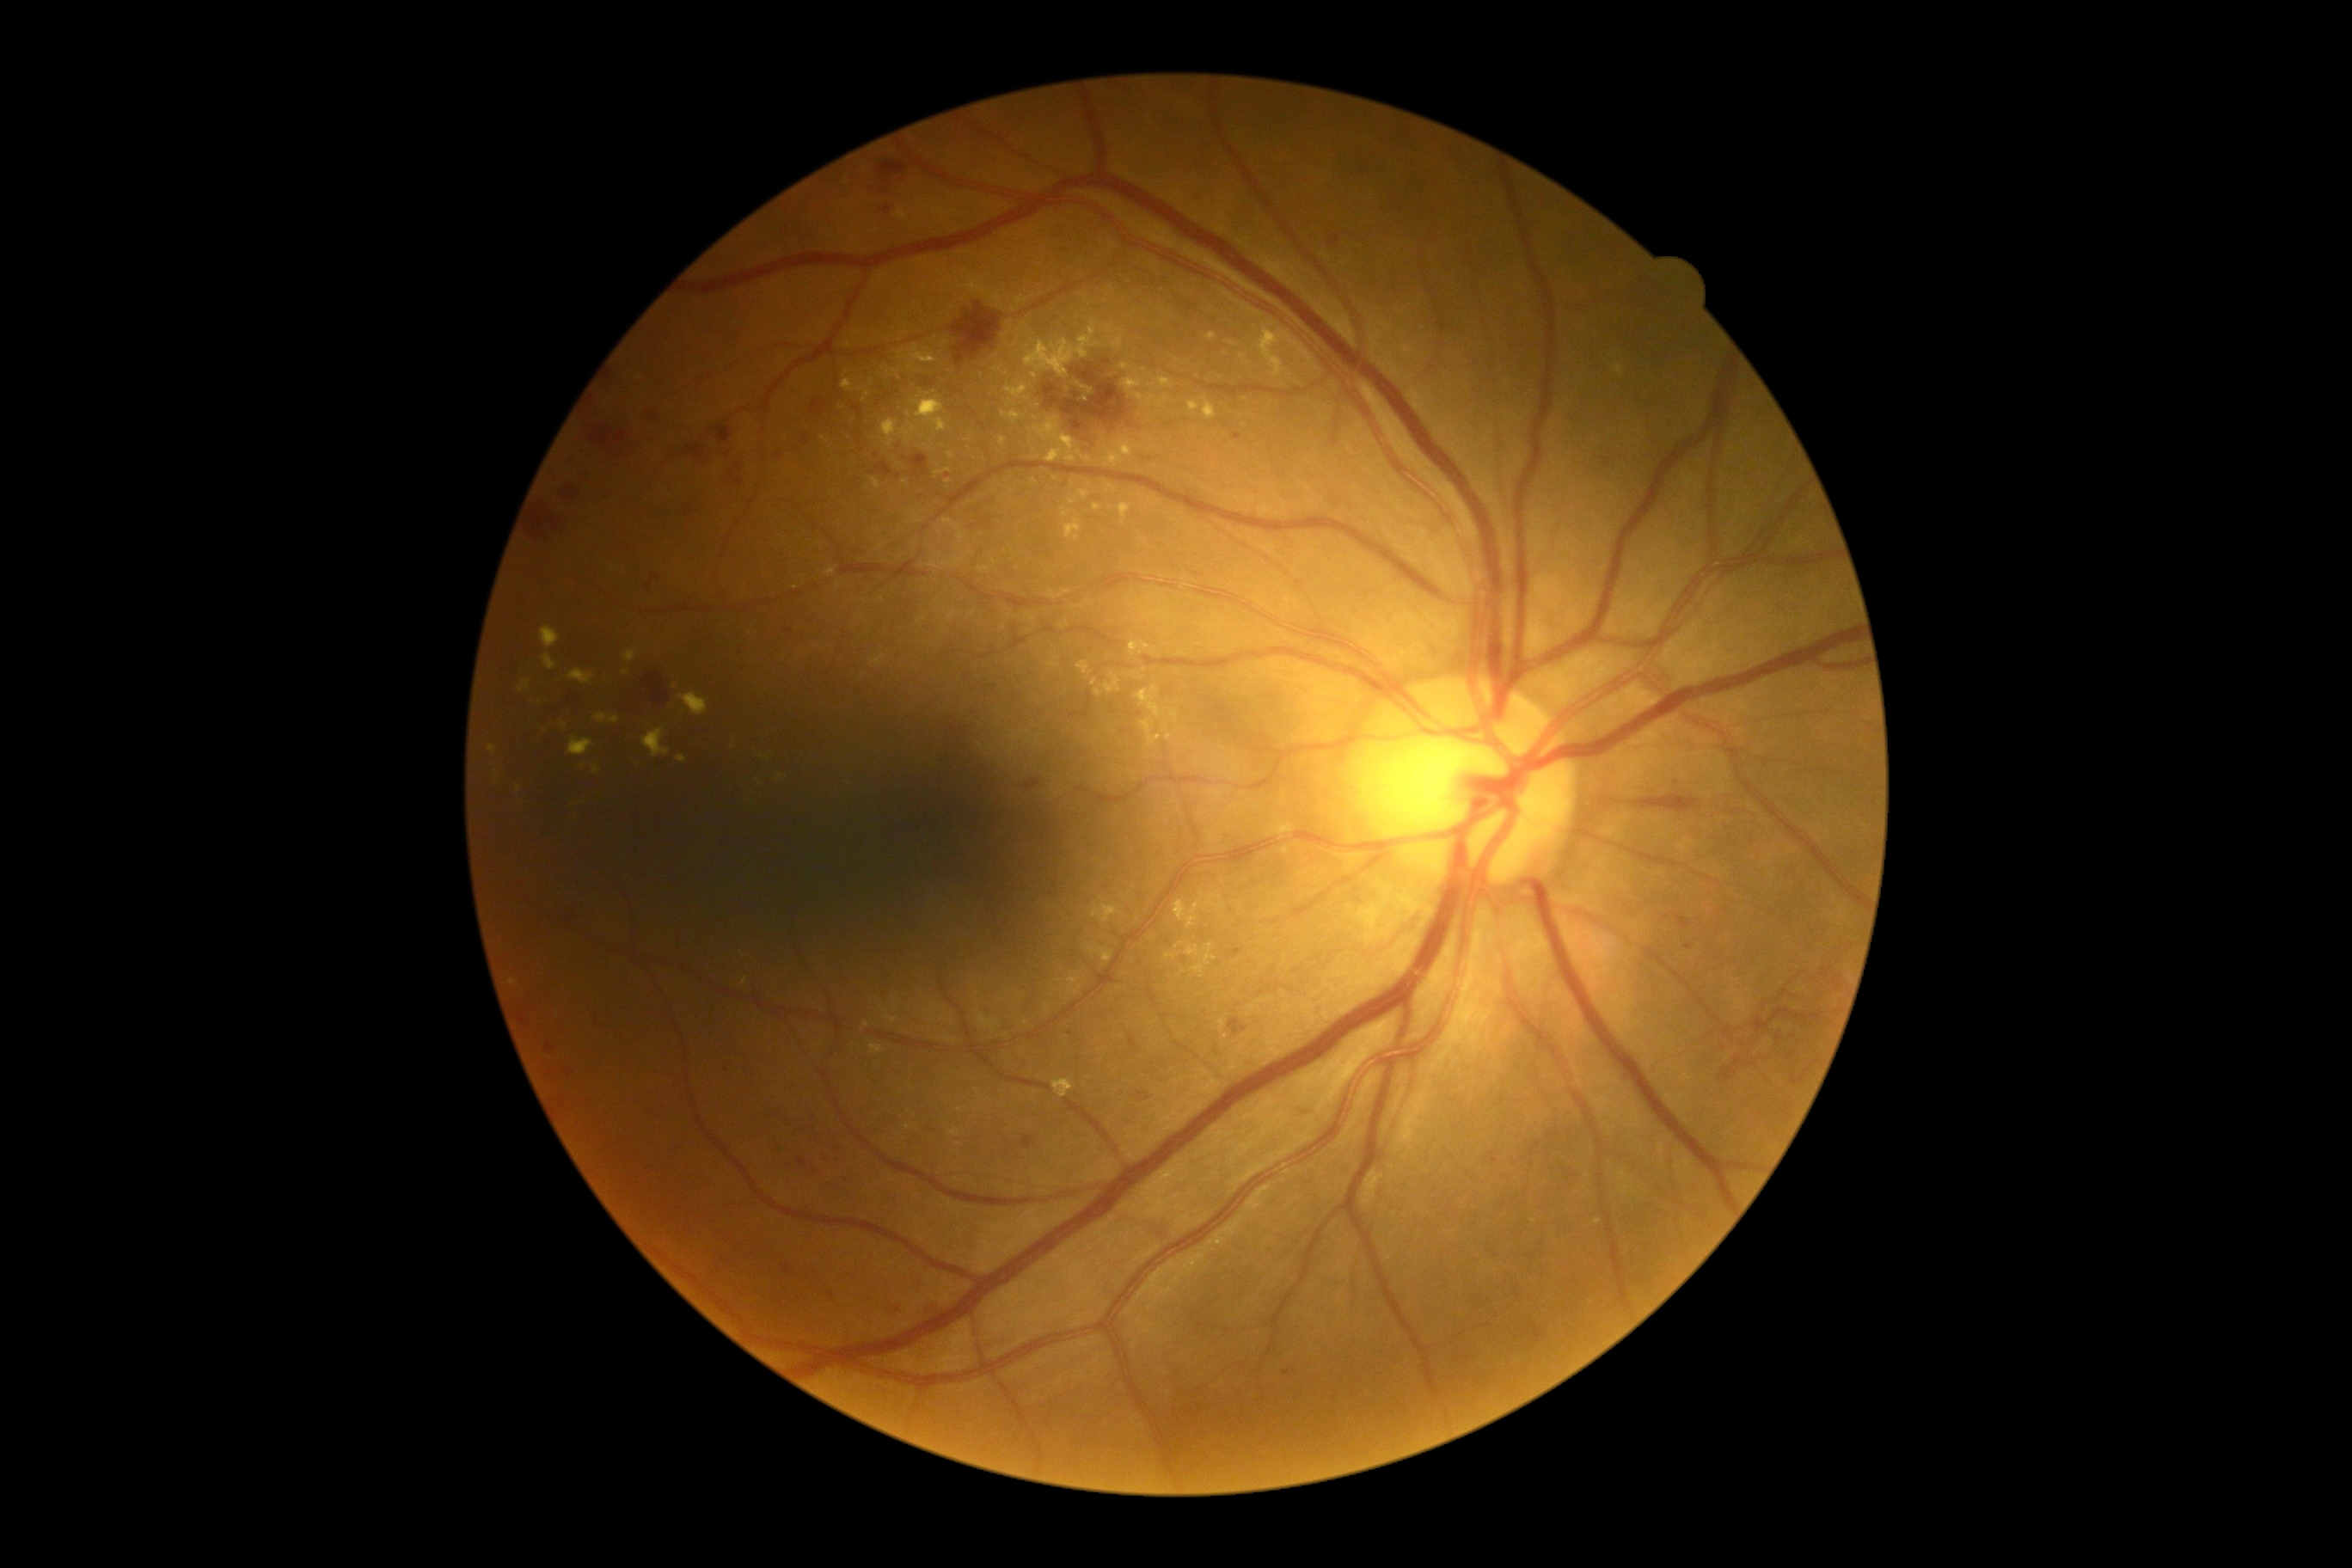
DR stage=severe non-proliferative diabetic retinopathy (grade 3); DR class=non-proliferative diabetic retinopathy.